NIDEK AFC-230; nonmydriatic fundus photograph; 45° FOV; 848 x 848 pixels.
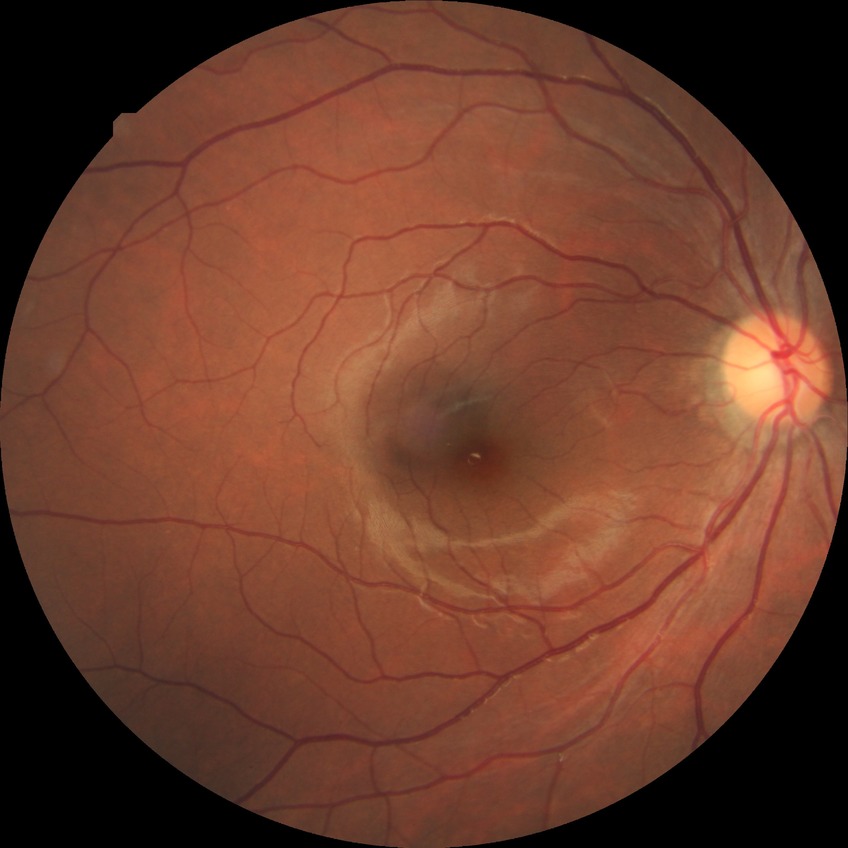

Findings:
• diabetic retinopathy (DR) — no diabetic retinopathy (NDR)